Kowa VX-10α: 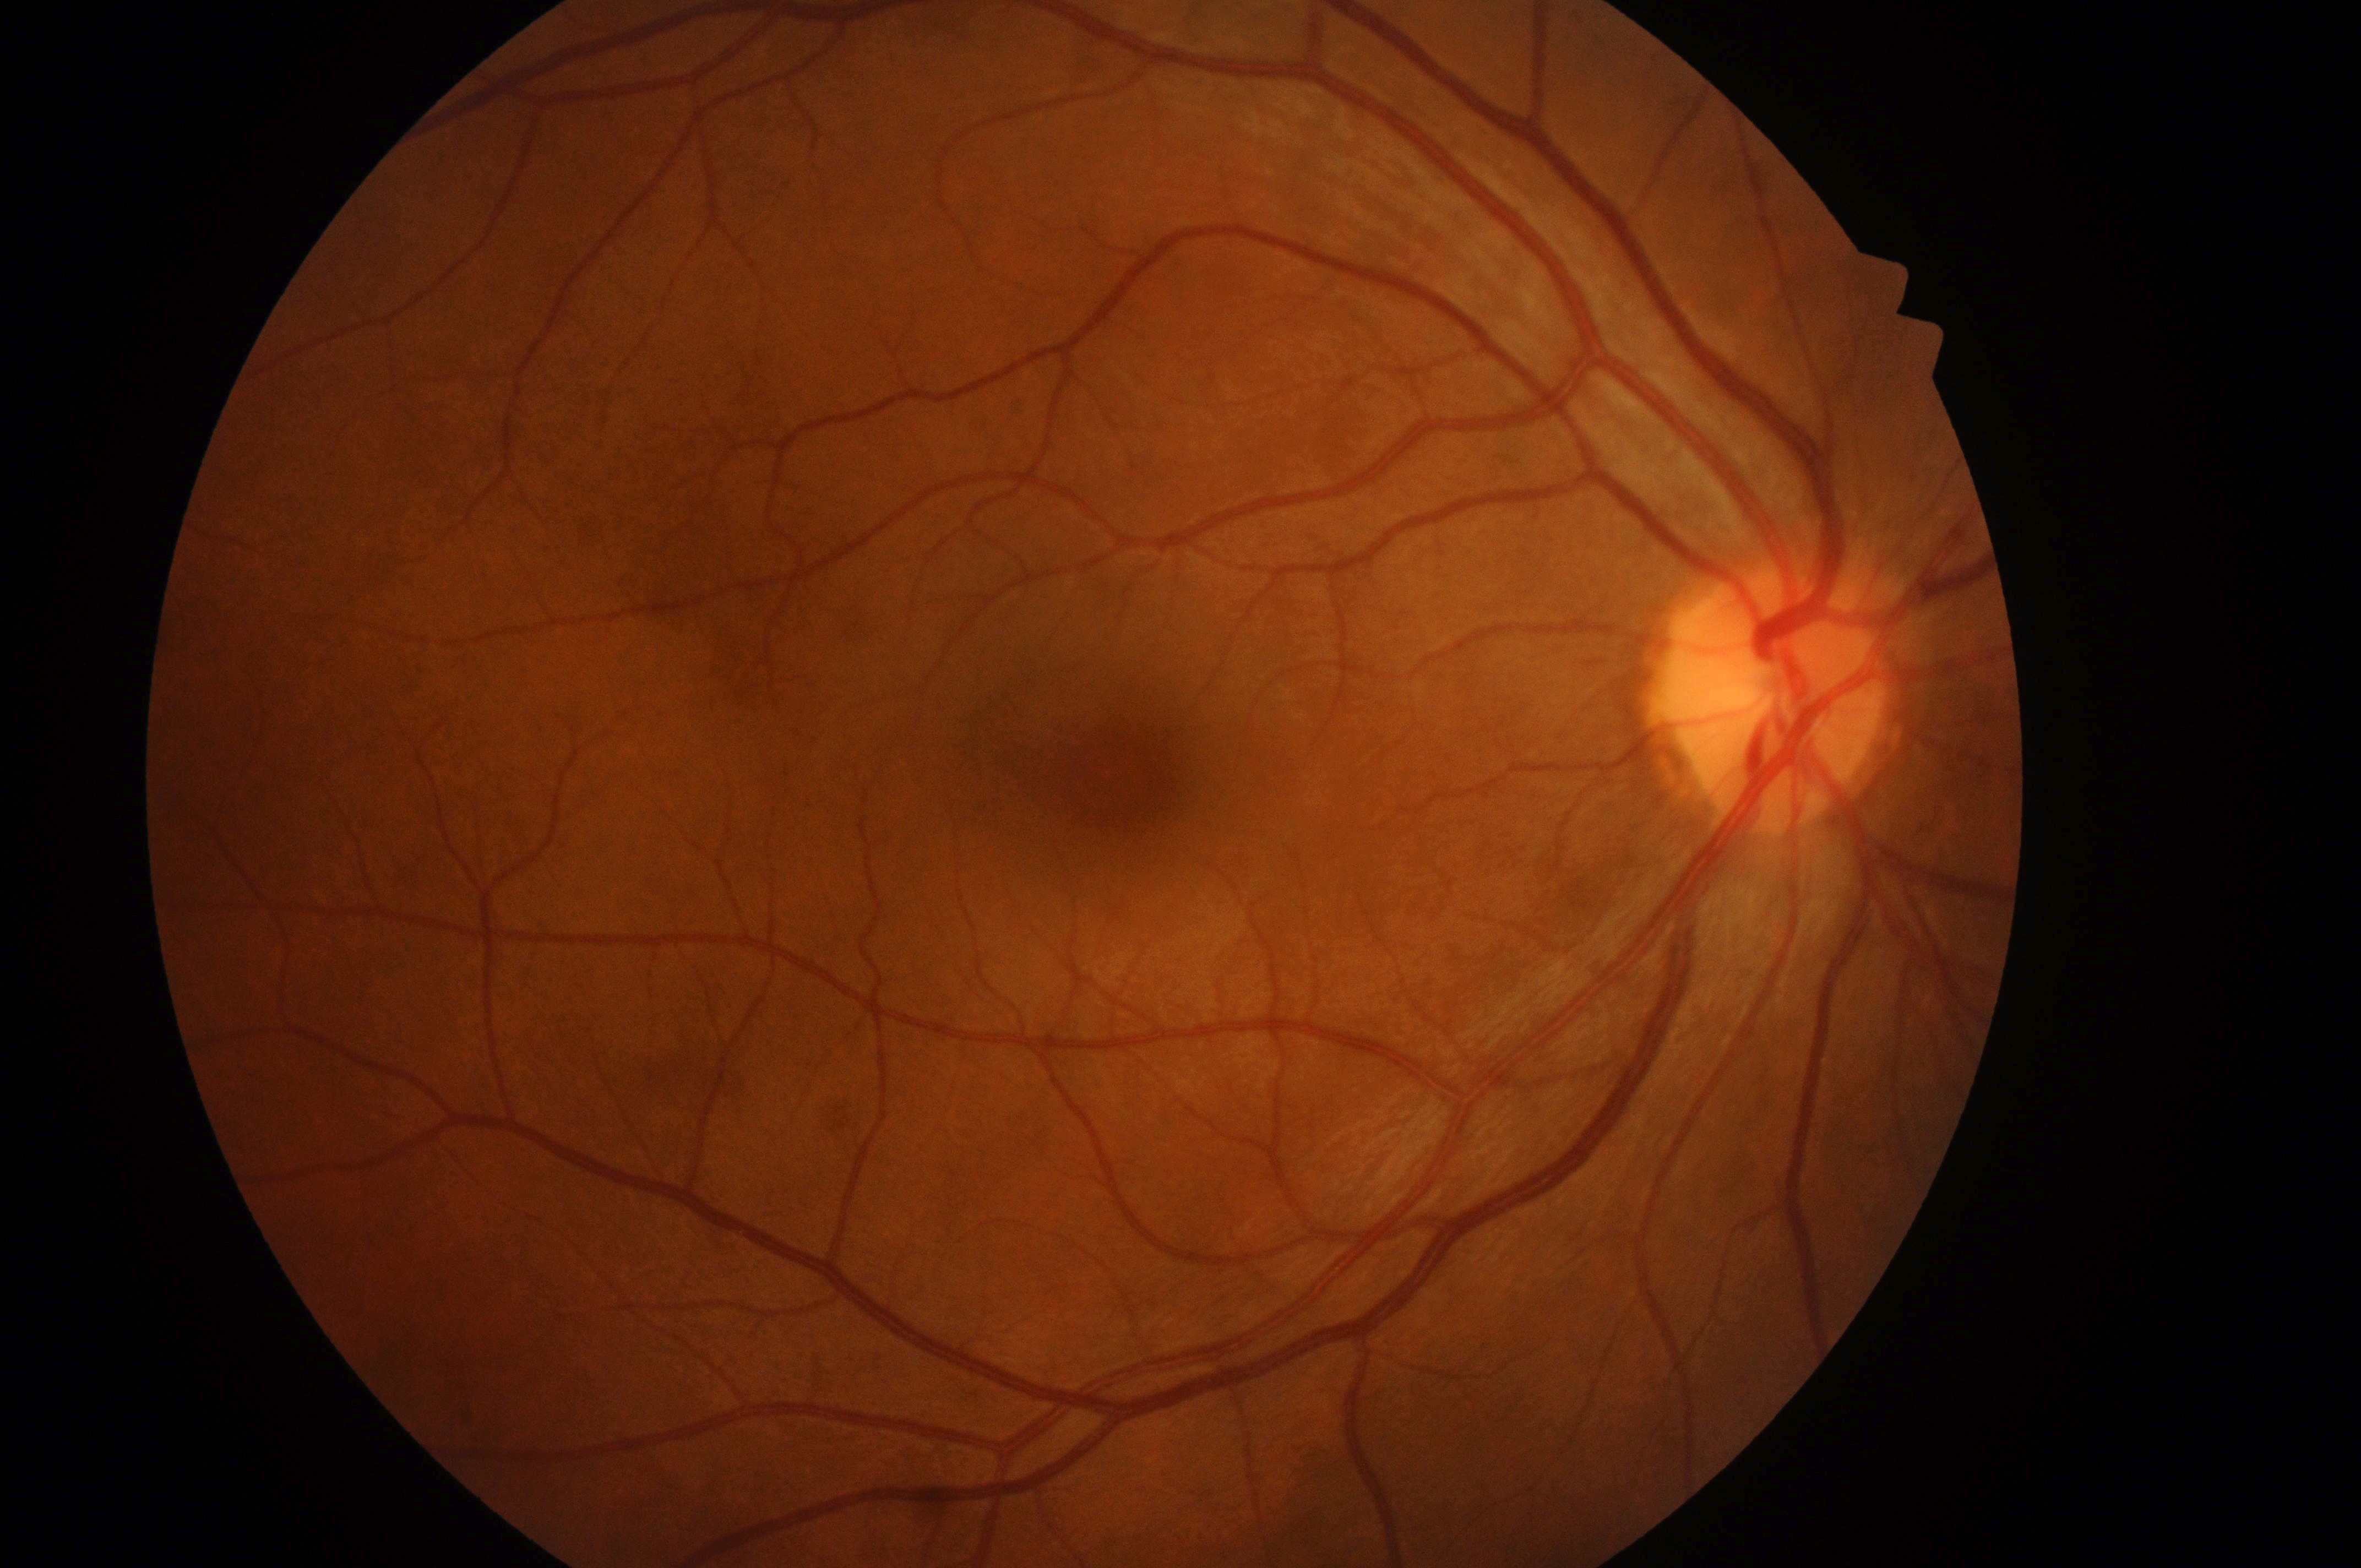 {"dr_grade": "no apparent retinopathy (grade 0) — no visible signs of diabetic retinopathy", "dr_impression": "No apparent diabetic retinopathy or macular edema", "optic_disc": "(x: 1772, y: 707)", "fovea": "(x: 1128, y: 775)", "eye": "oculus dexter", "dme_grade": "no risk (grade 0) — no apparent hard exudates"}